Camera: Clarity RetCam 3 (130° FOV). Infant wide-field retinal image.
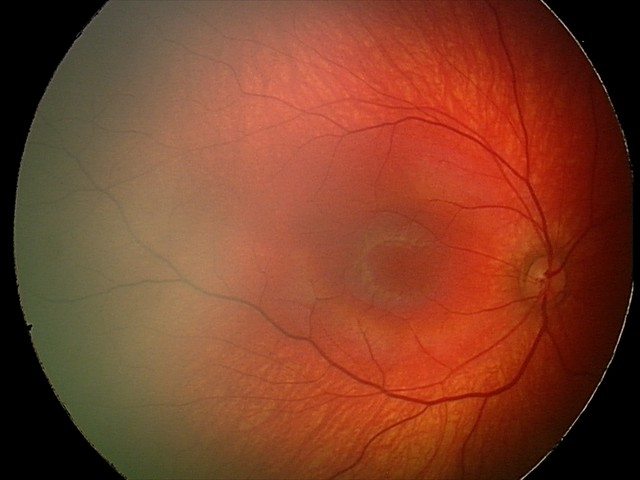

Diagnosis: normal retinal appearance.